Topcon TRC fundus camera · 35° FOV before cropping · ONH-centered crop from a color fundus image:
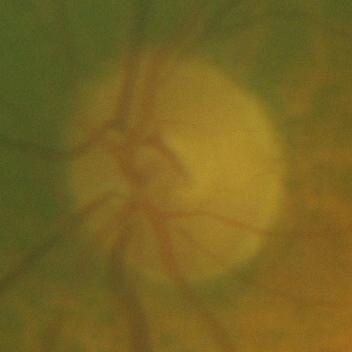 There is evidence of no glaucomatous findings.